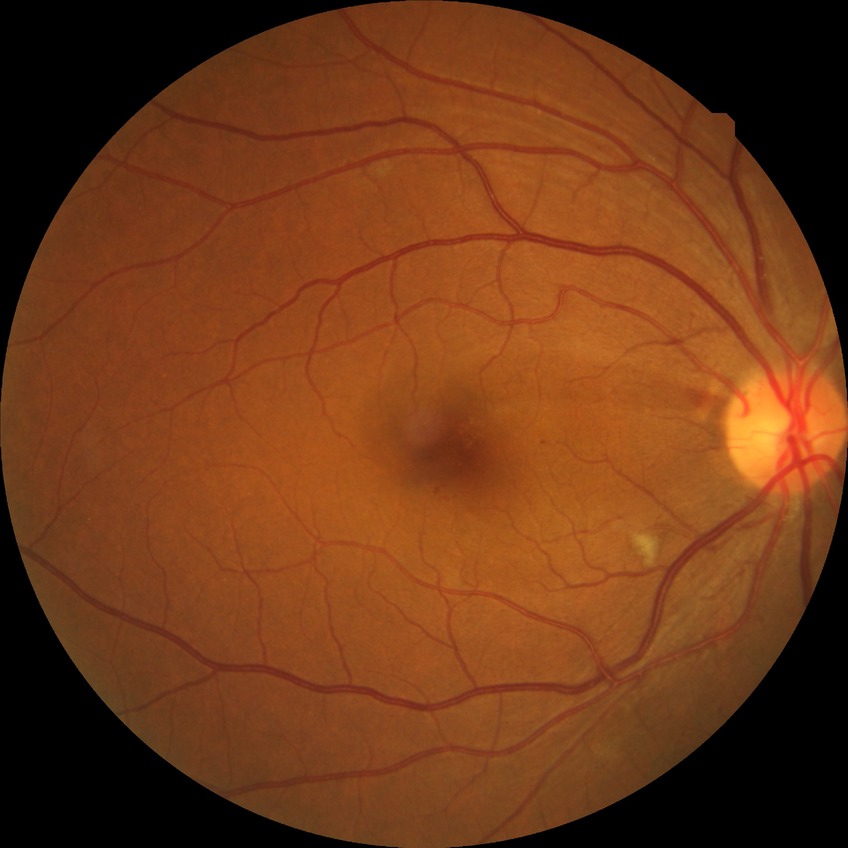

Diabetic retinopathy (DR) is SDR (simple diabetic retinopathy).